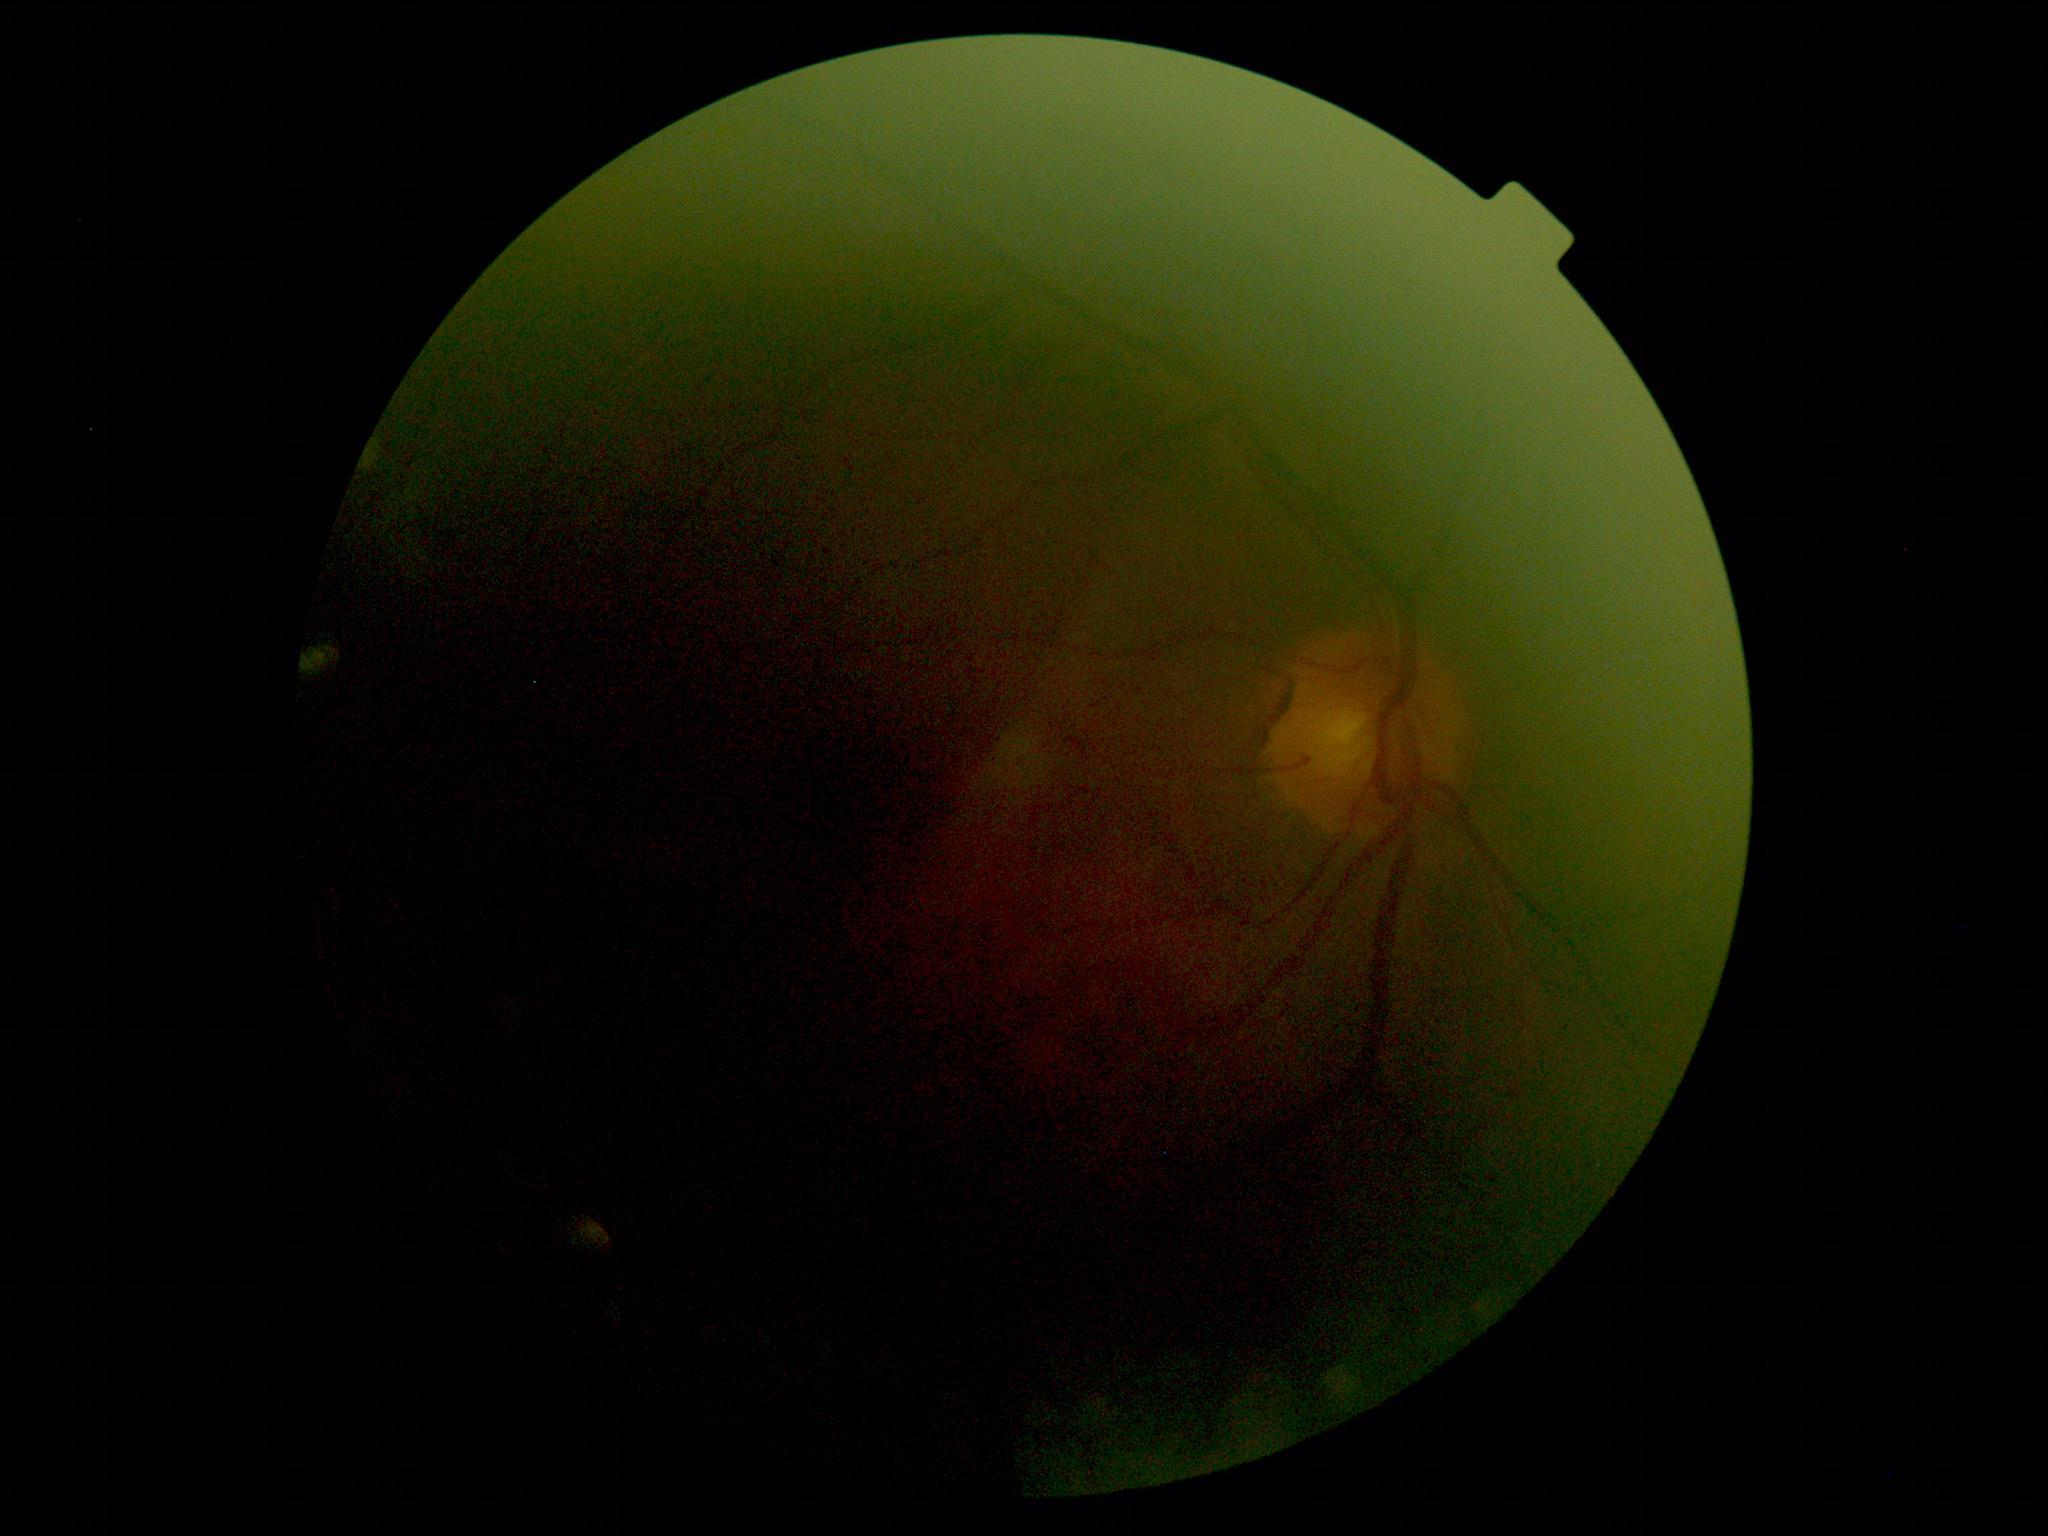
diabetic retinopathy (DR) = ungradable due to poor image quality.